Infant wide-field fundus photograph — 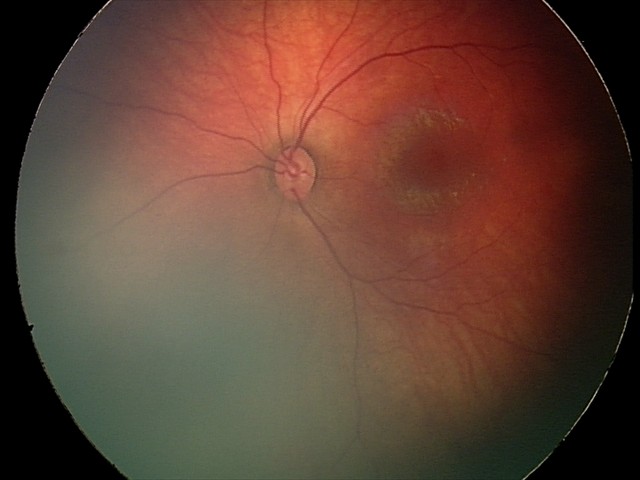 Series diagnosed as retinal hemorrhages.